RetCam wide-field infant fundus image
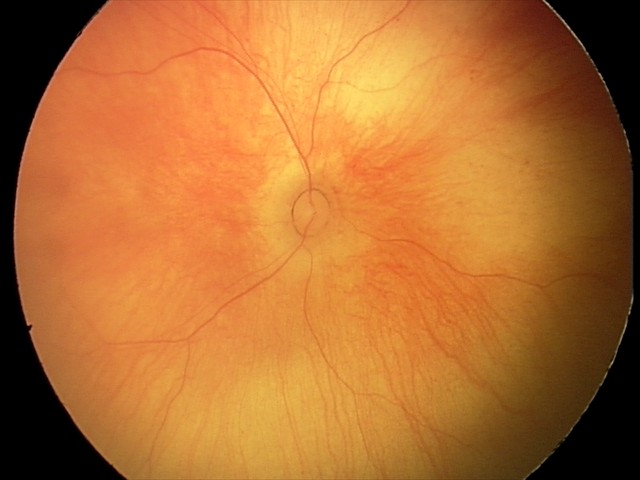
Examination with physiological retinal findings.